2102 by 1736 pixels · retinal fundus photograph.
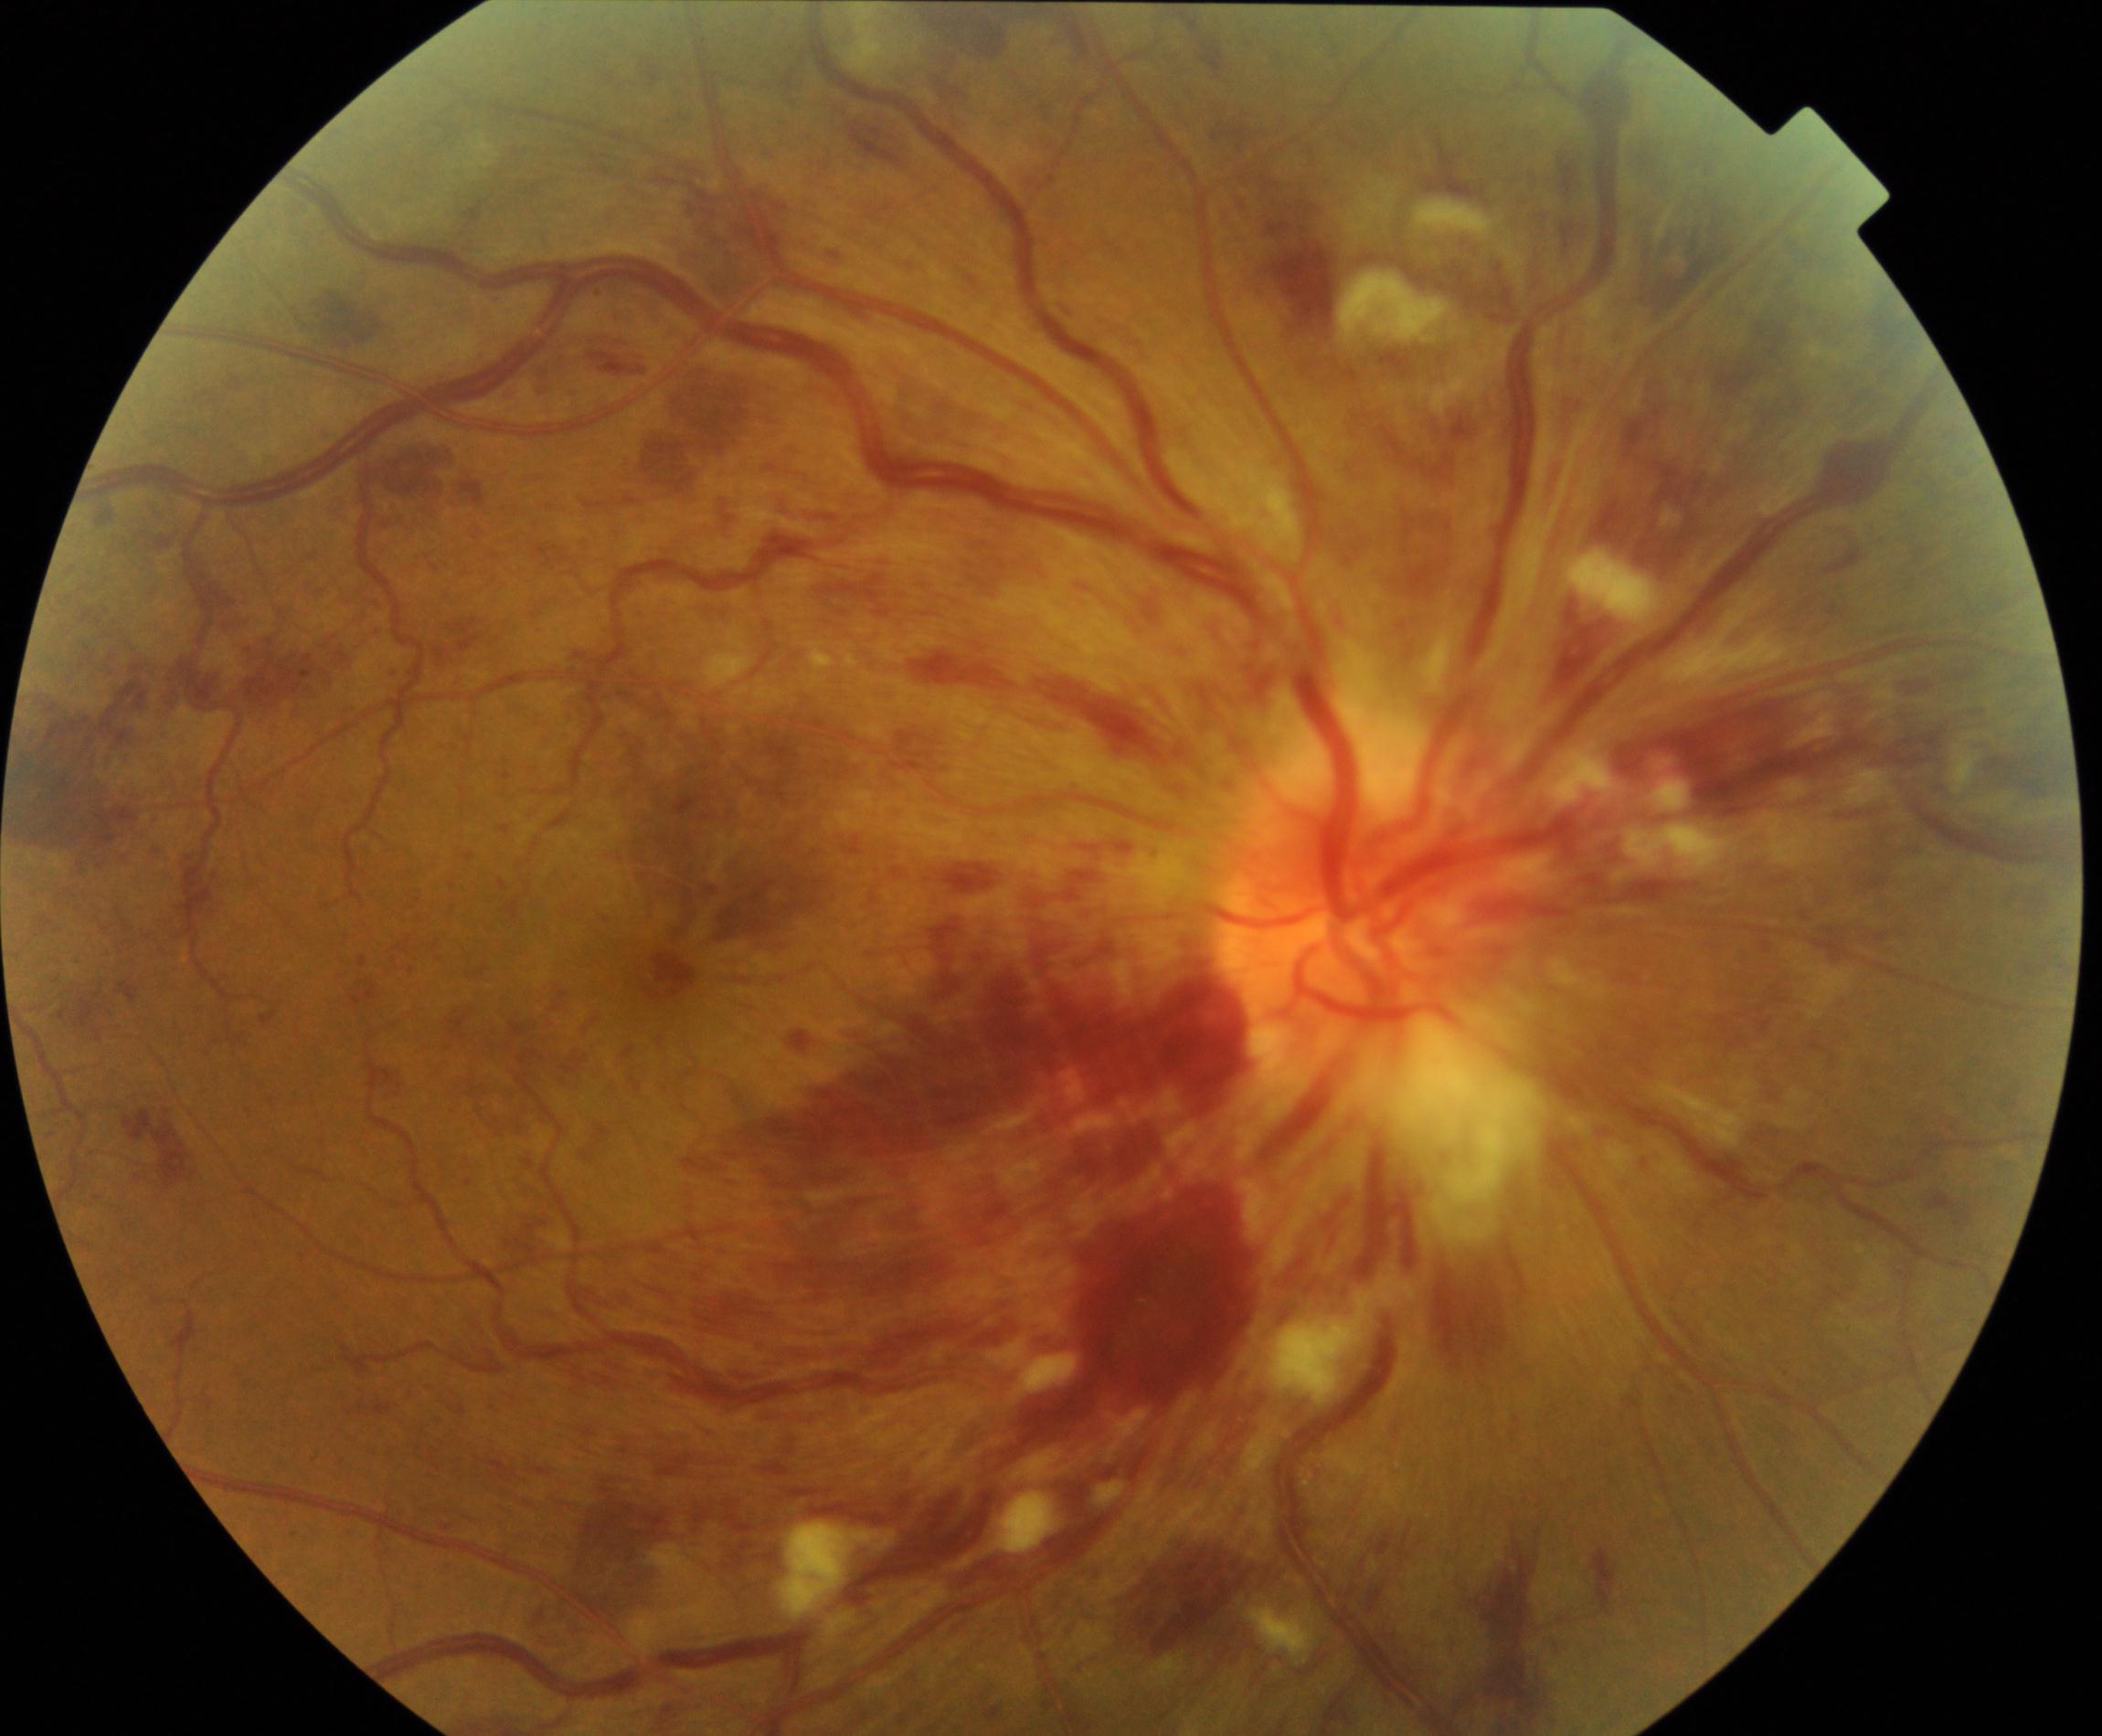

Findings consistent with central retinal vein occlusion. Features include tortuosity and dilatation of all branches of veins, with dot, blot, and flame hemorrhages, sometimes with cotton-wool spots or hard exudates.